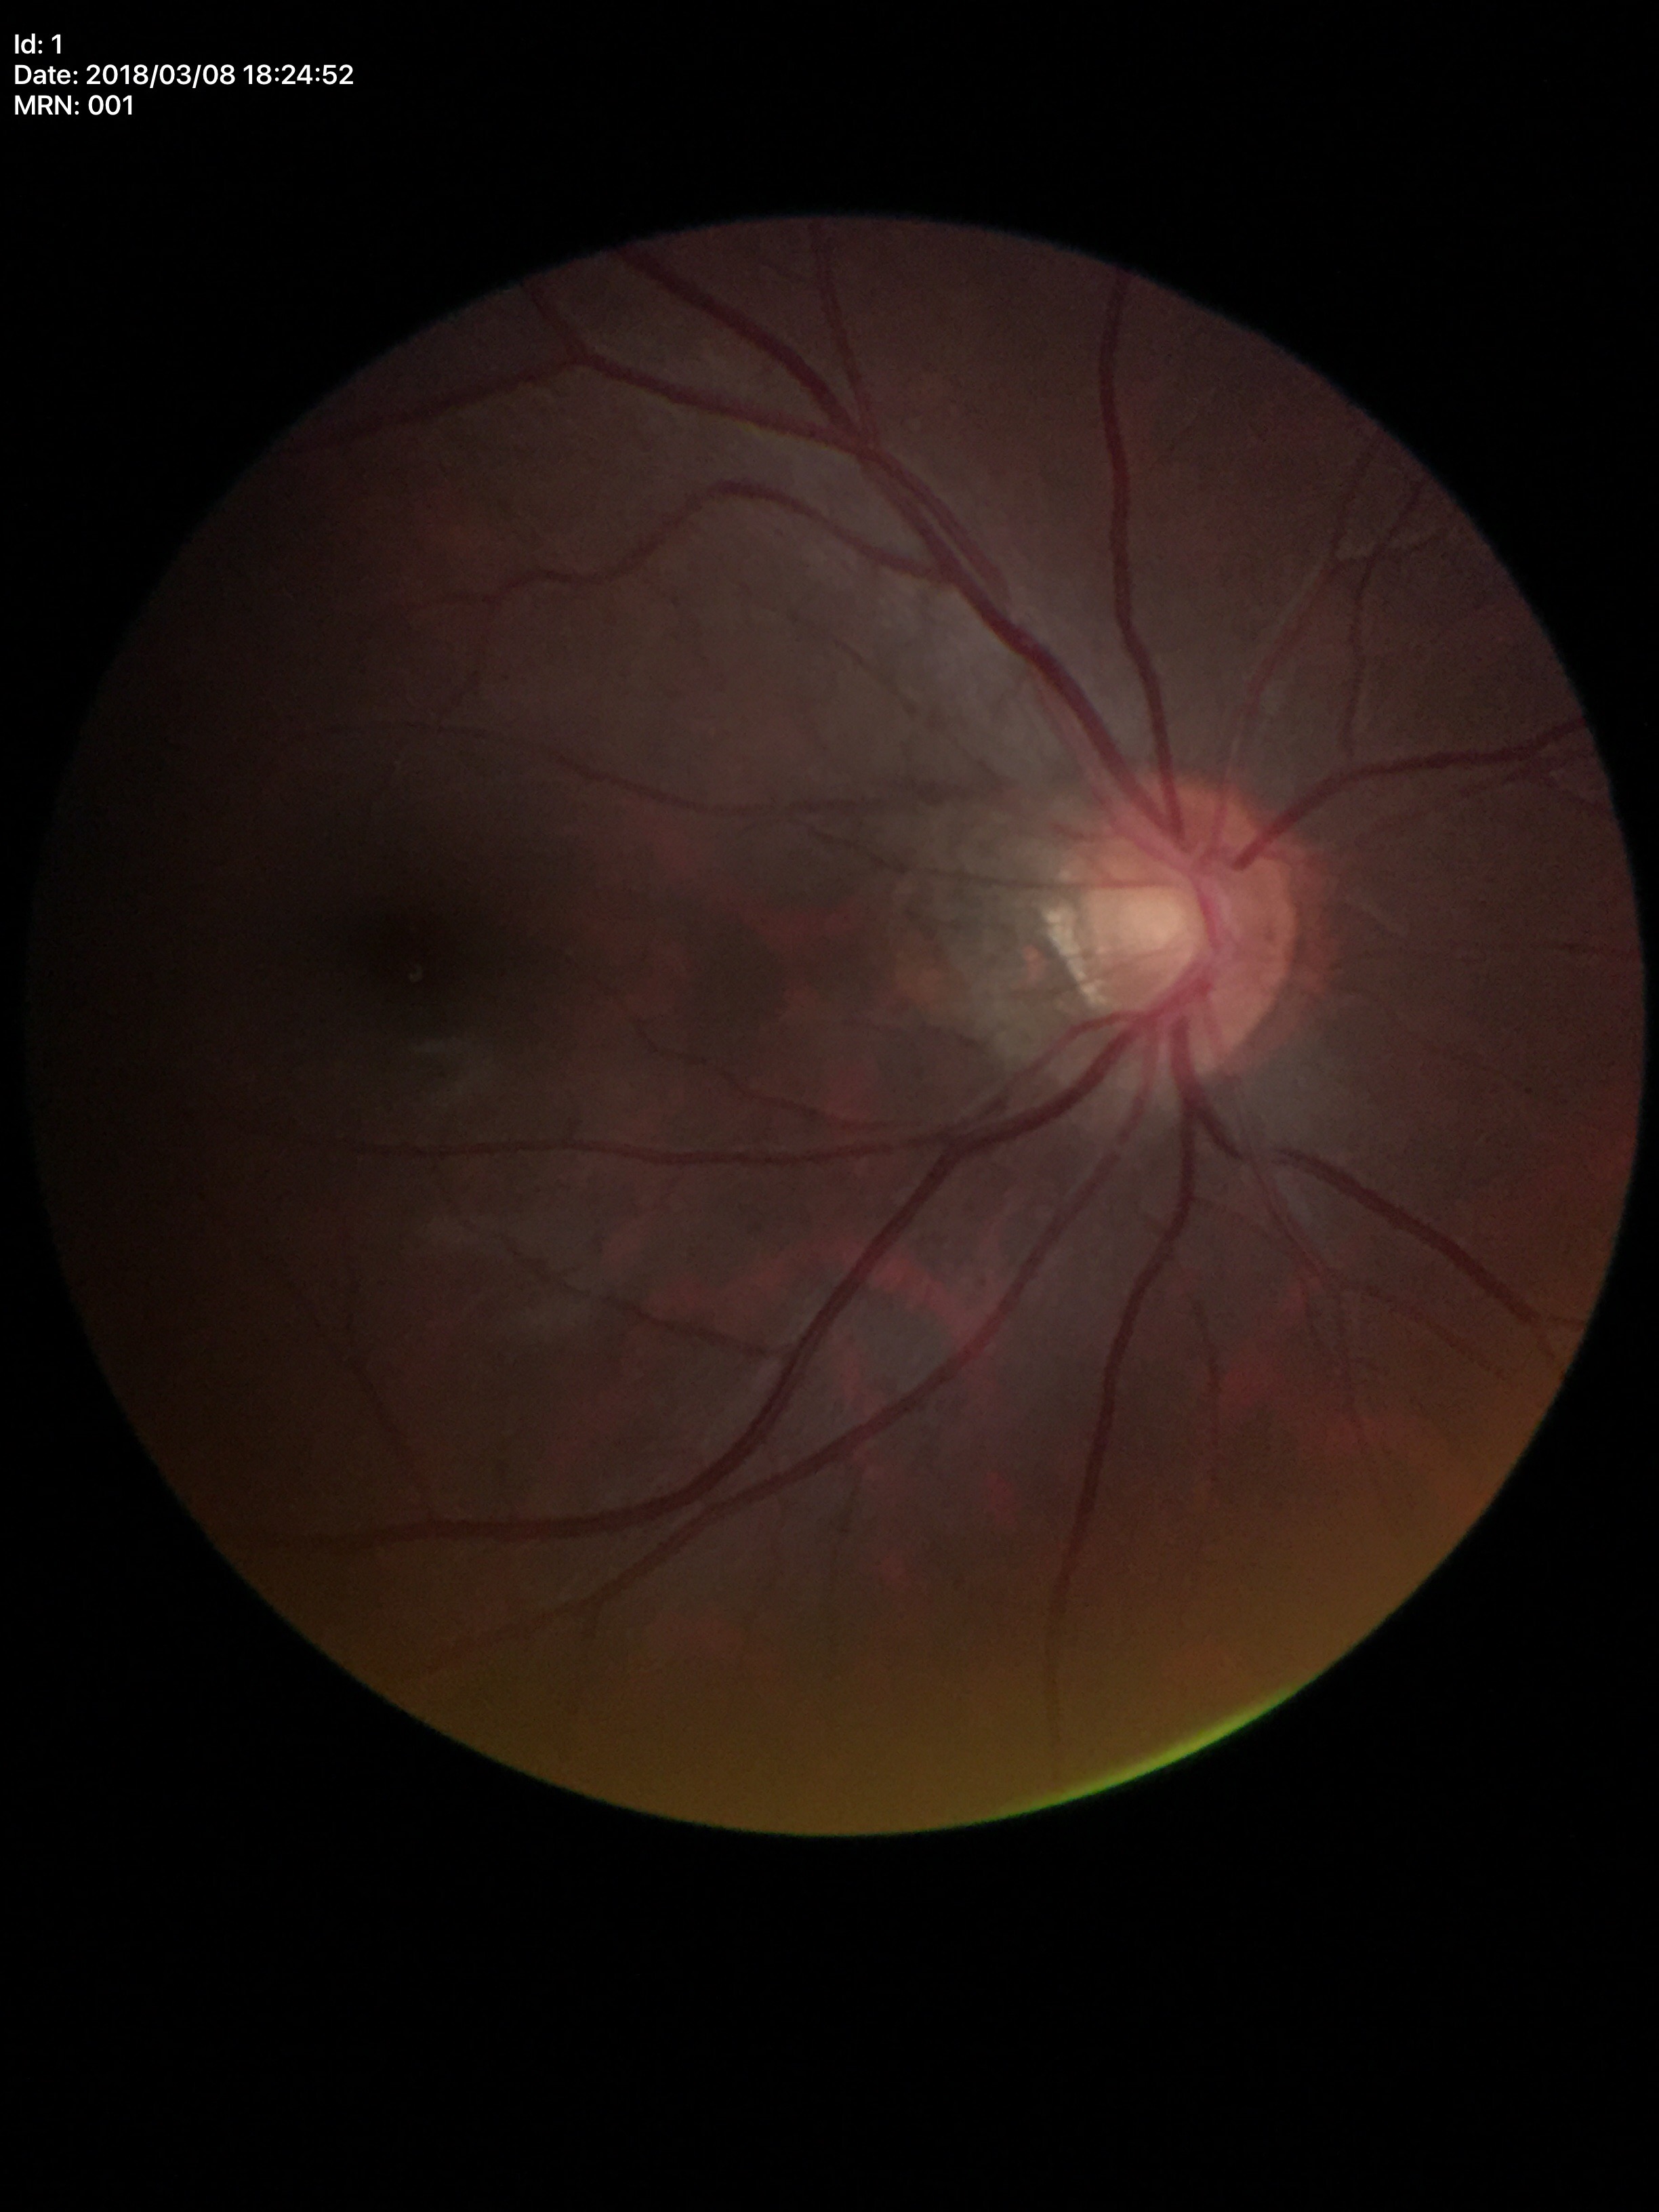 Glaucoma assessment=negative (unanimous normal call)
vertical cup-to-disc ratio (VCDR)=0.45